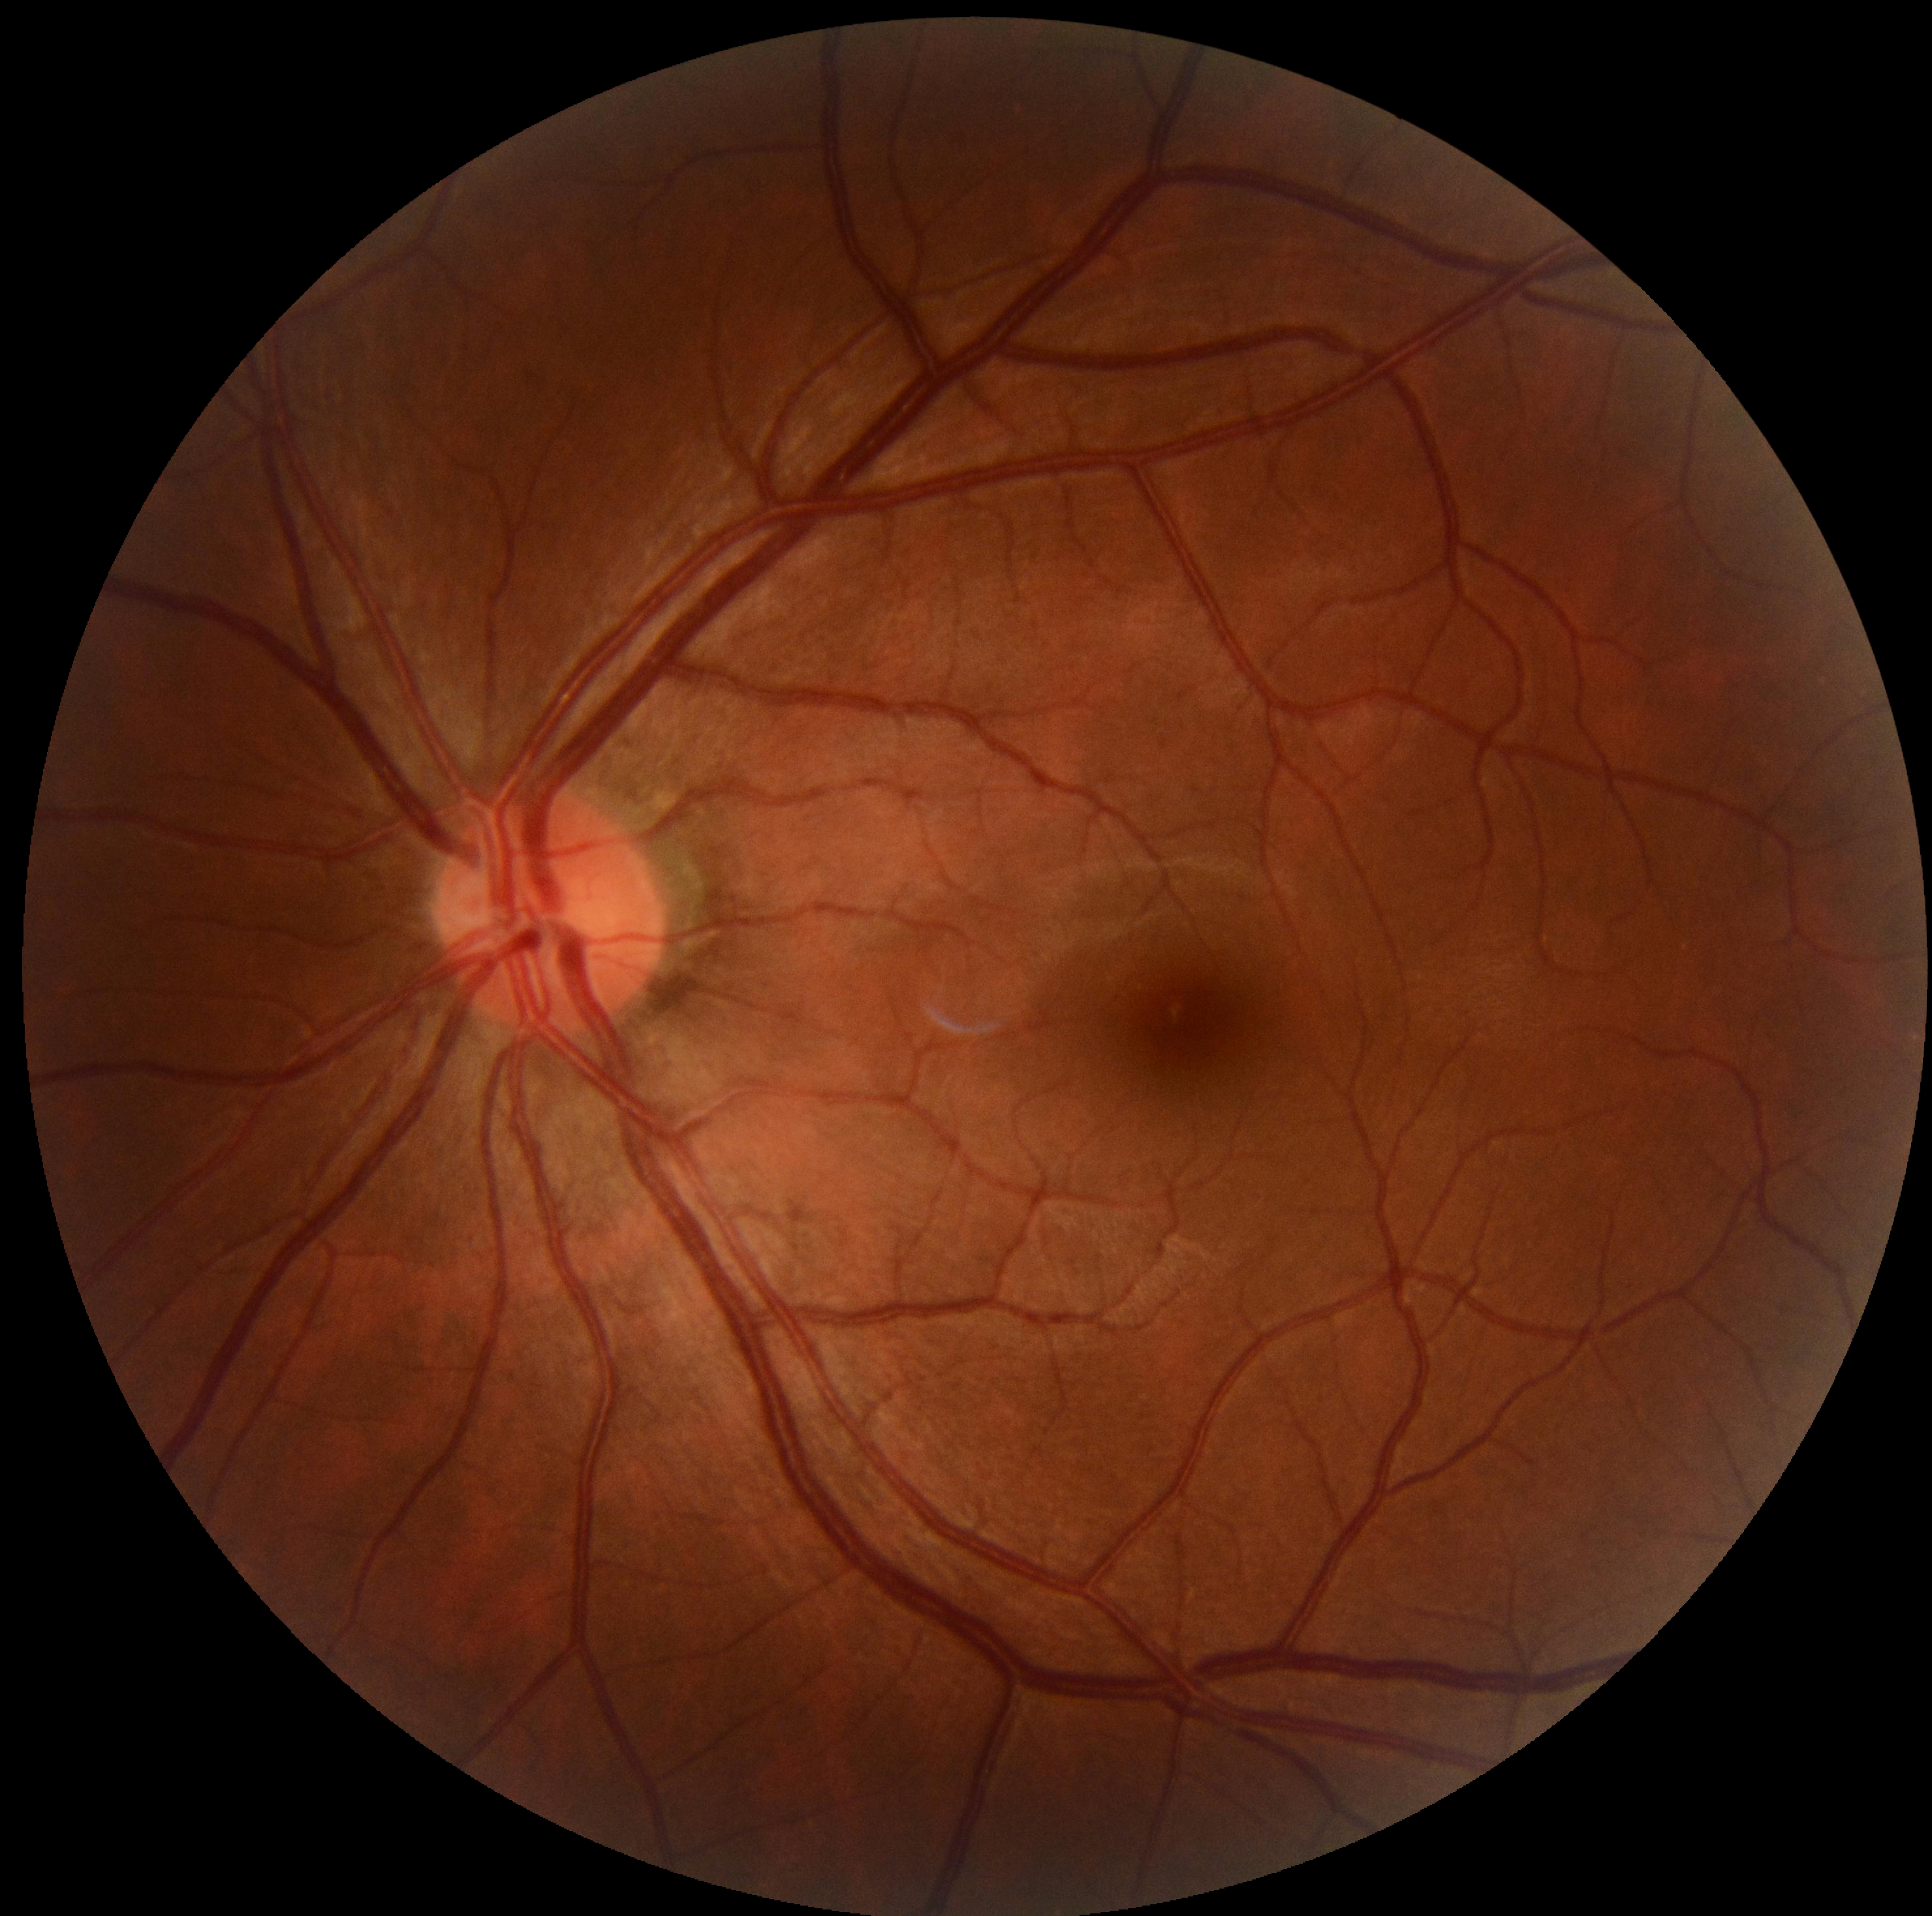

DR stage: grade 0 (no apparent retinopathy).